DR severity per modified Davis staging — 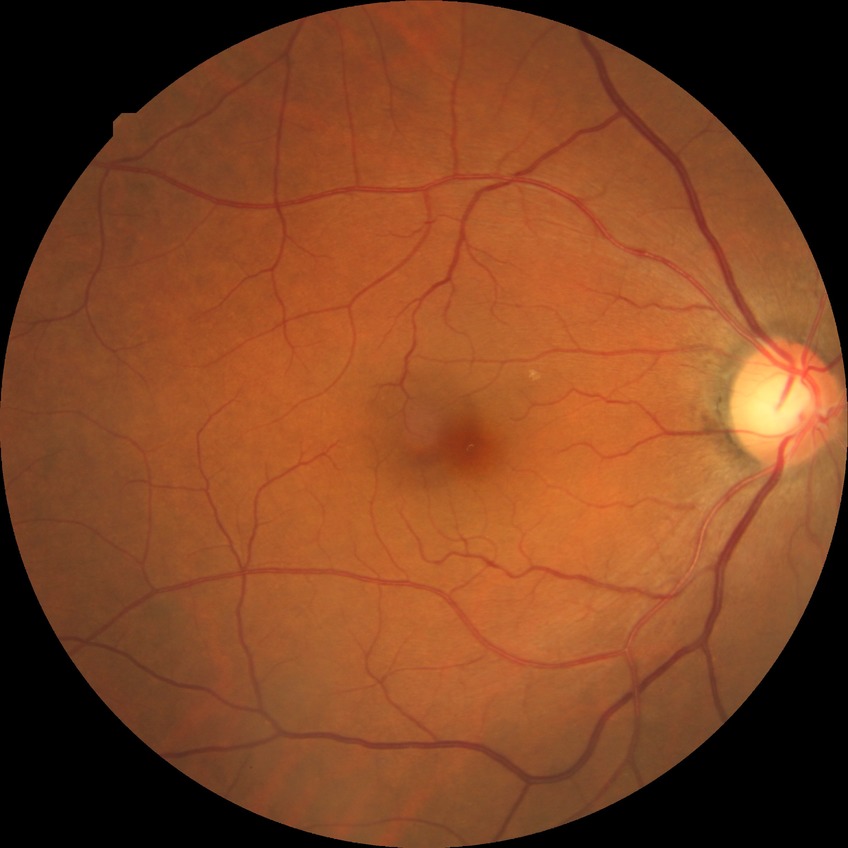 Diabetic retinopathy (DR): simple diabetic retinopathy (SDR).